45° FOV — 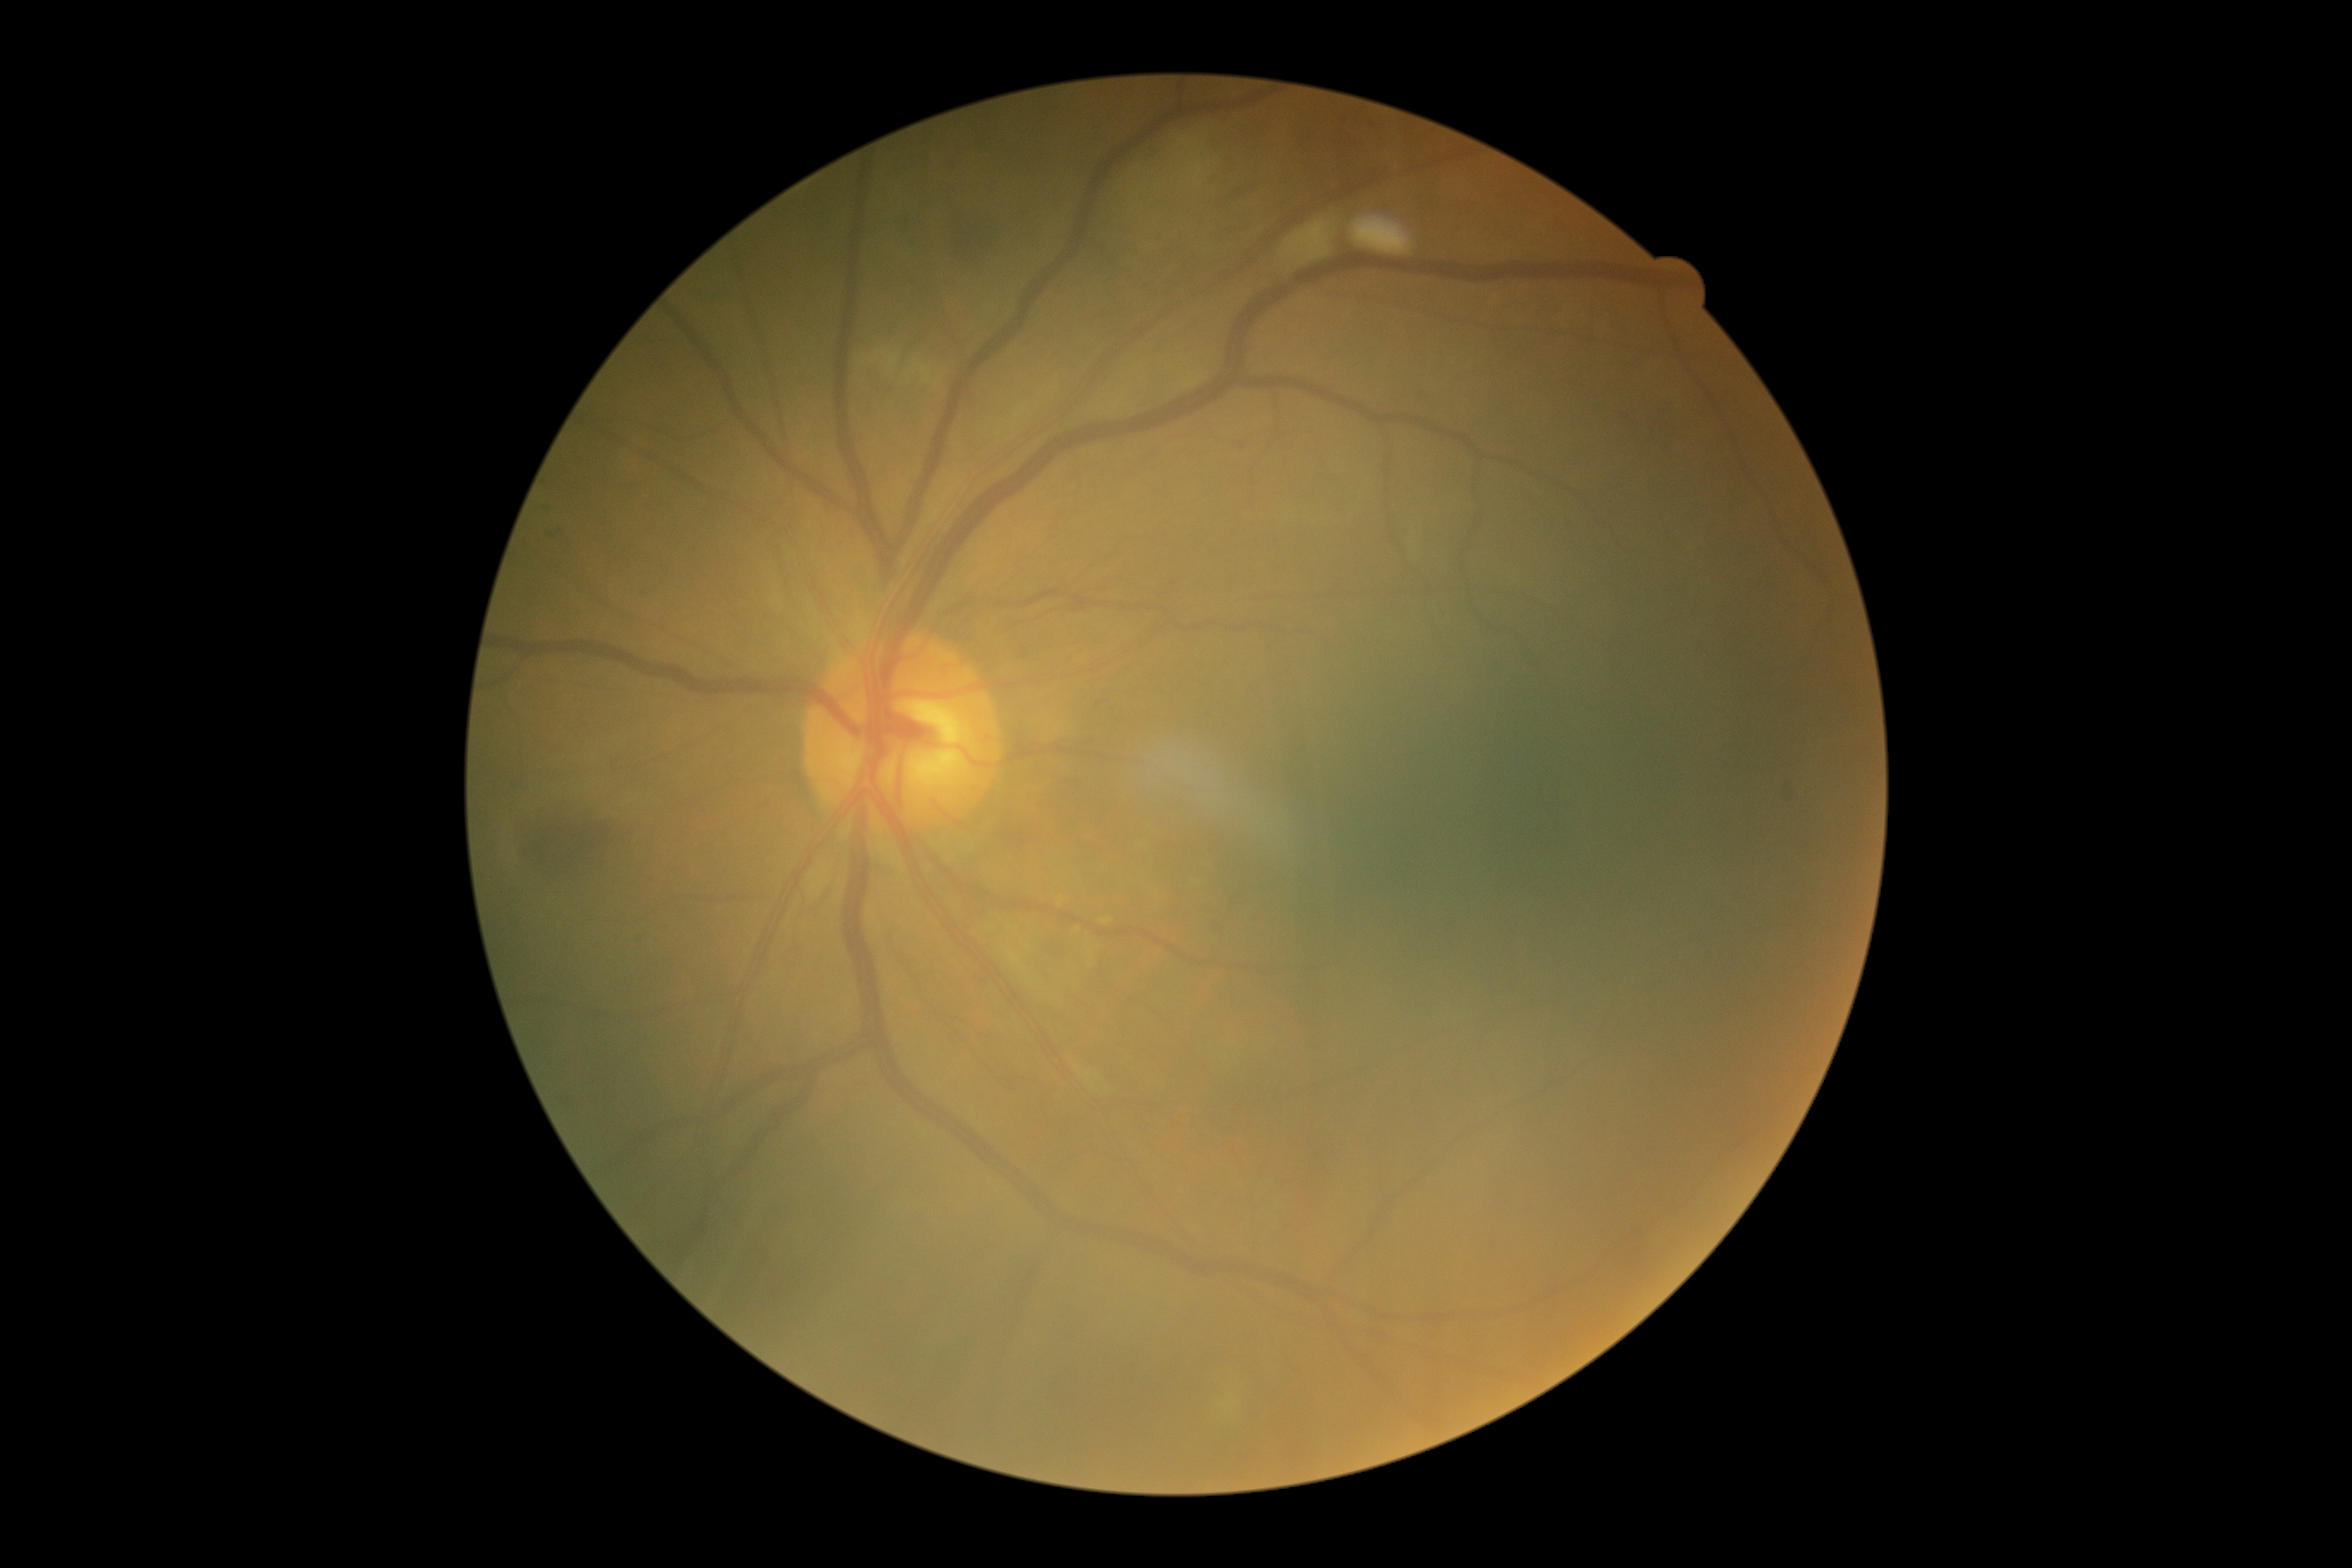
DR severity: moderate non-proliferative diabetic retinopathy (grade 2). Disease class: non-proliferative diabetic retinopathy.